Color fundus photograph · 2352x1568px: 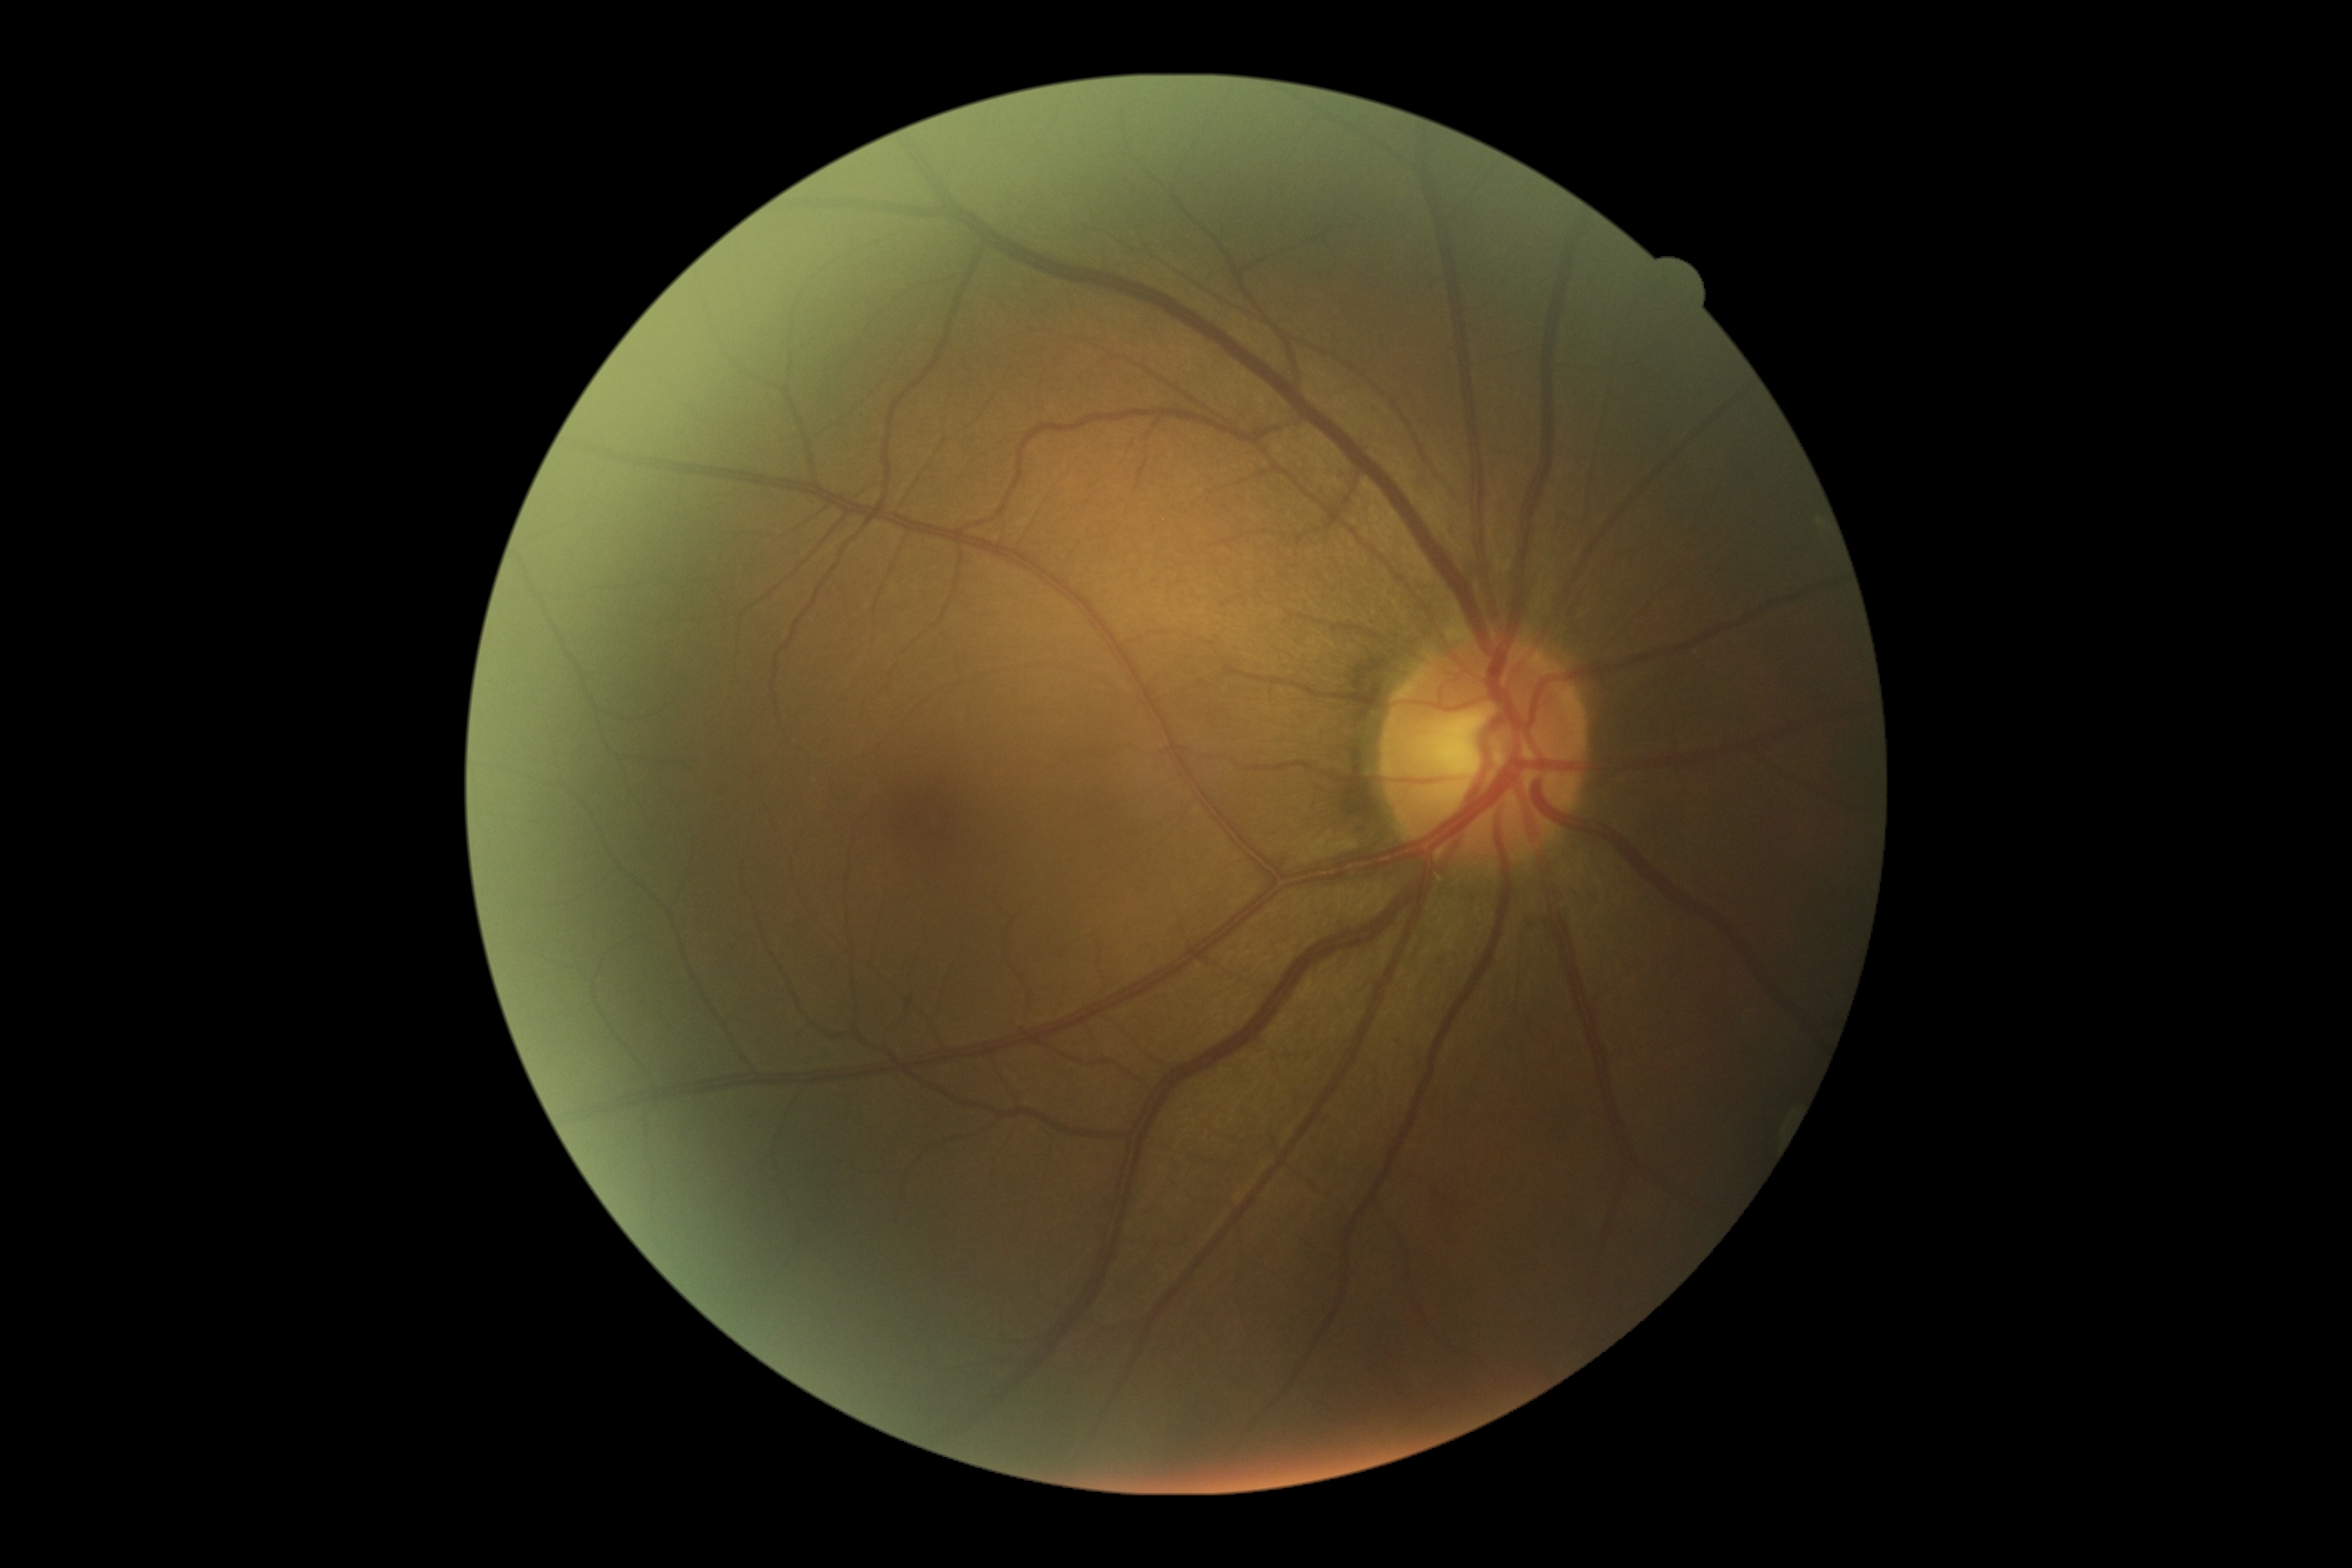

DR grade: 0 — no visible signs of diabetic retinopathy.